CFP.
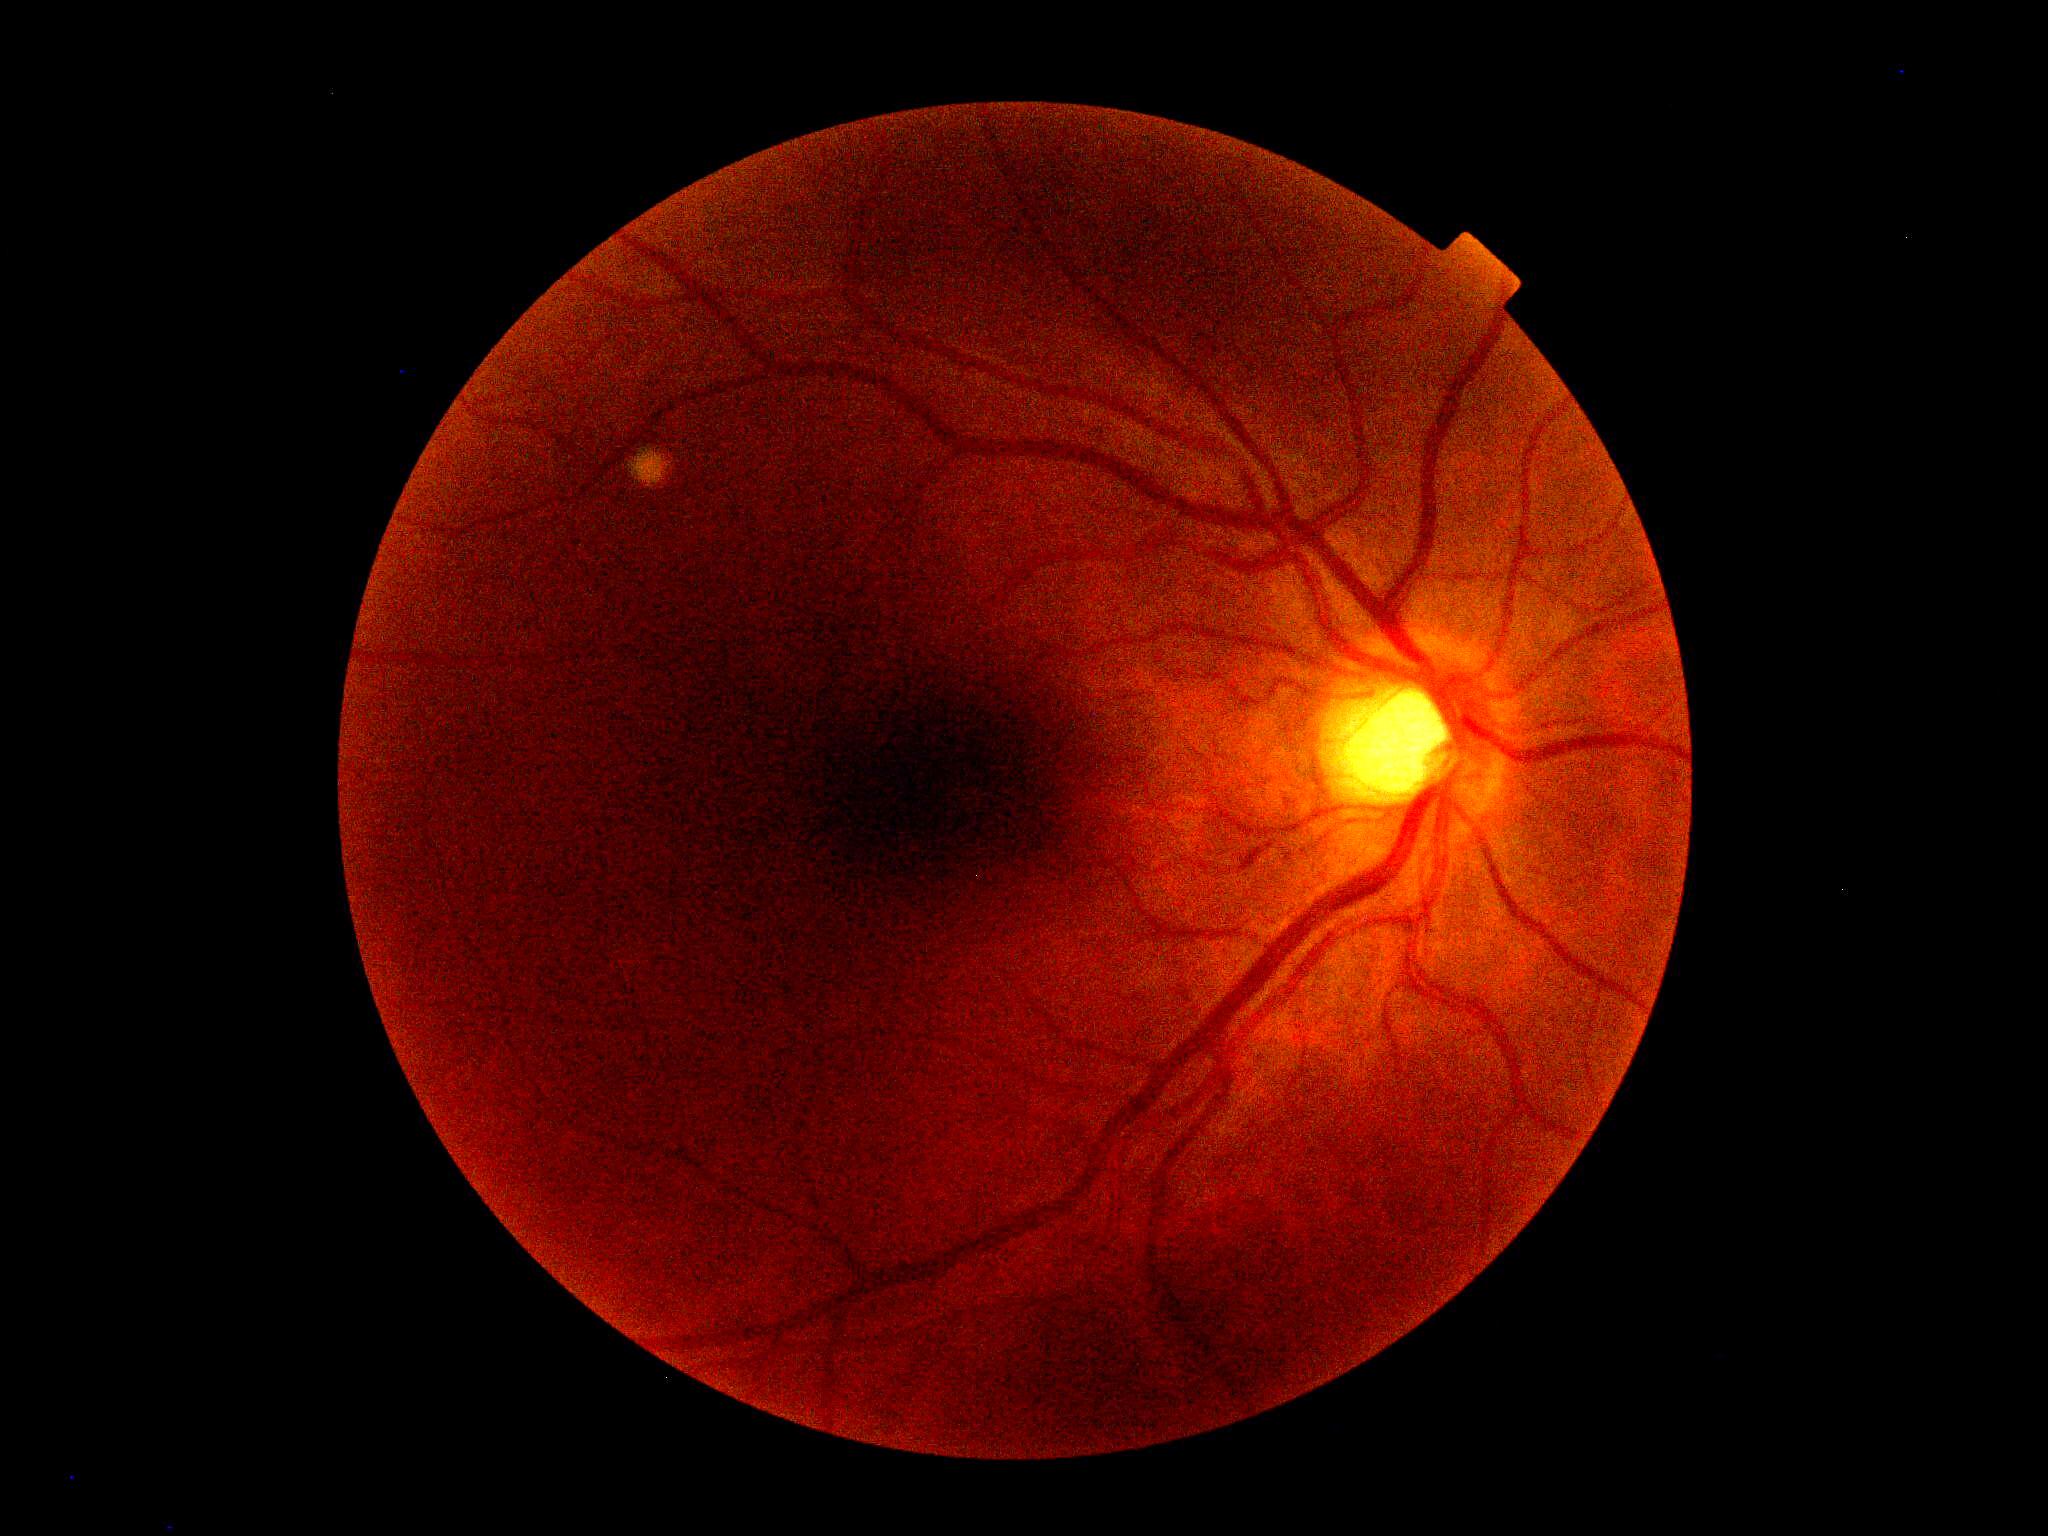

No DR findings. Diabetic retinopathy: no apparent retinopathy (grade 0).